Graded on the modified Davis scale.
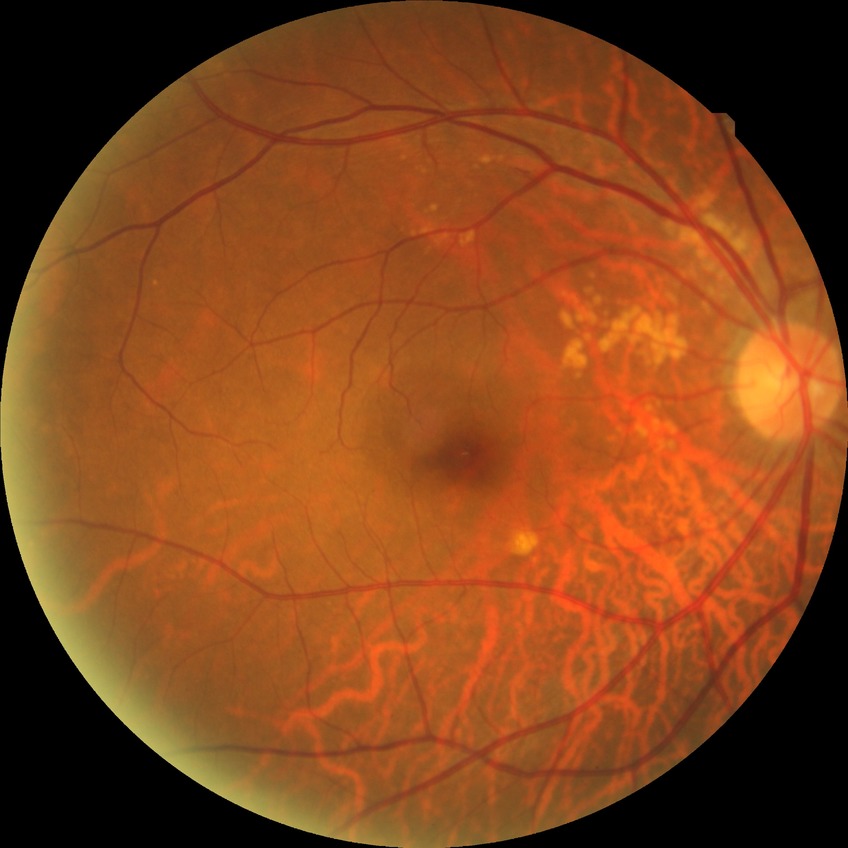

DR stage is NDR.